848x848:
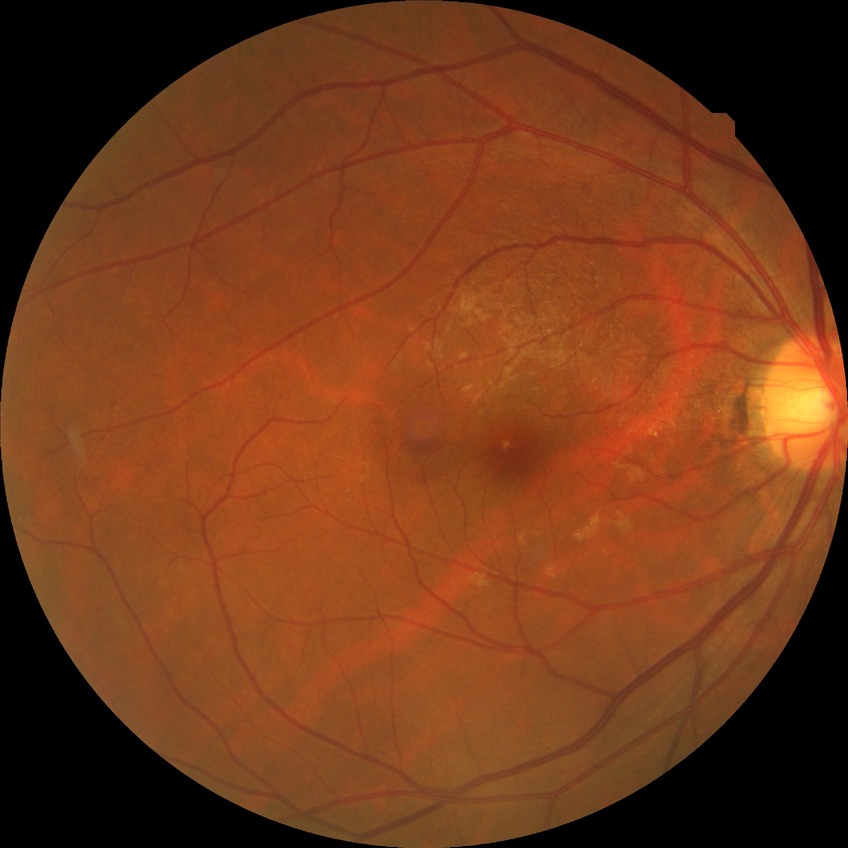 {"davis_grade": "NDR (no diabetic retinopathy)"}